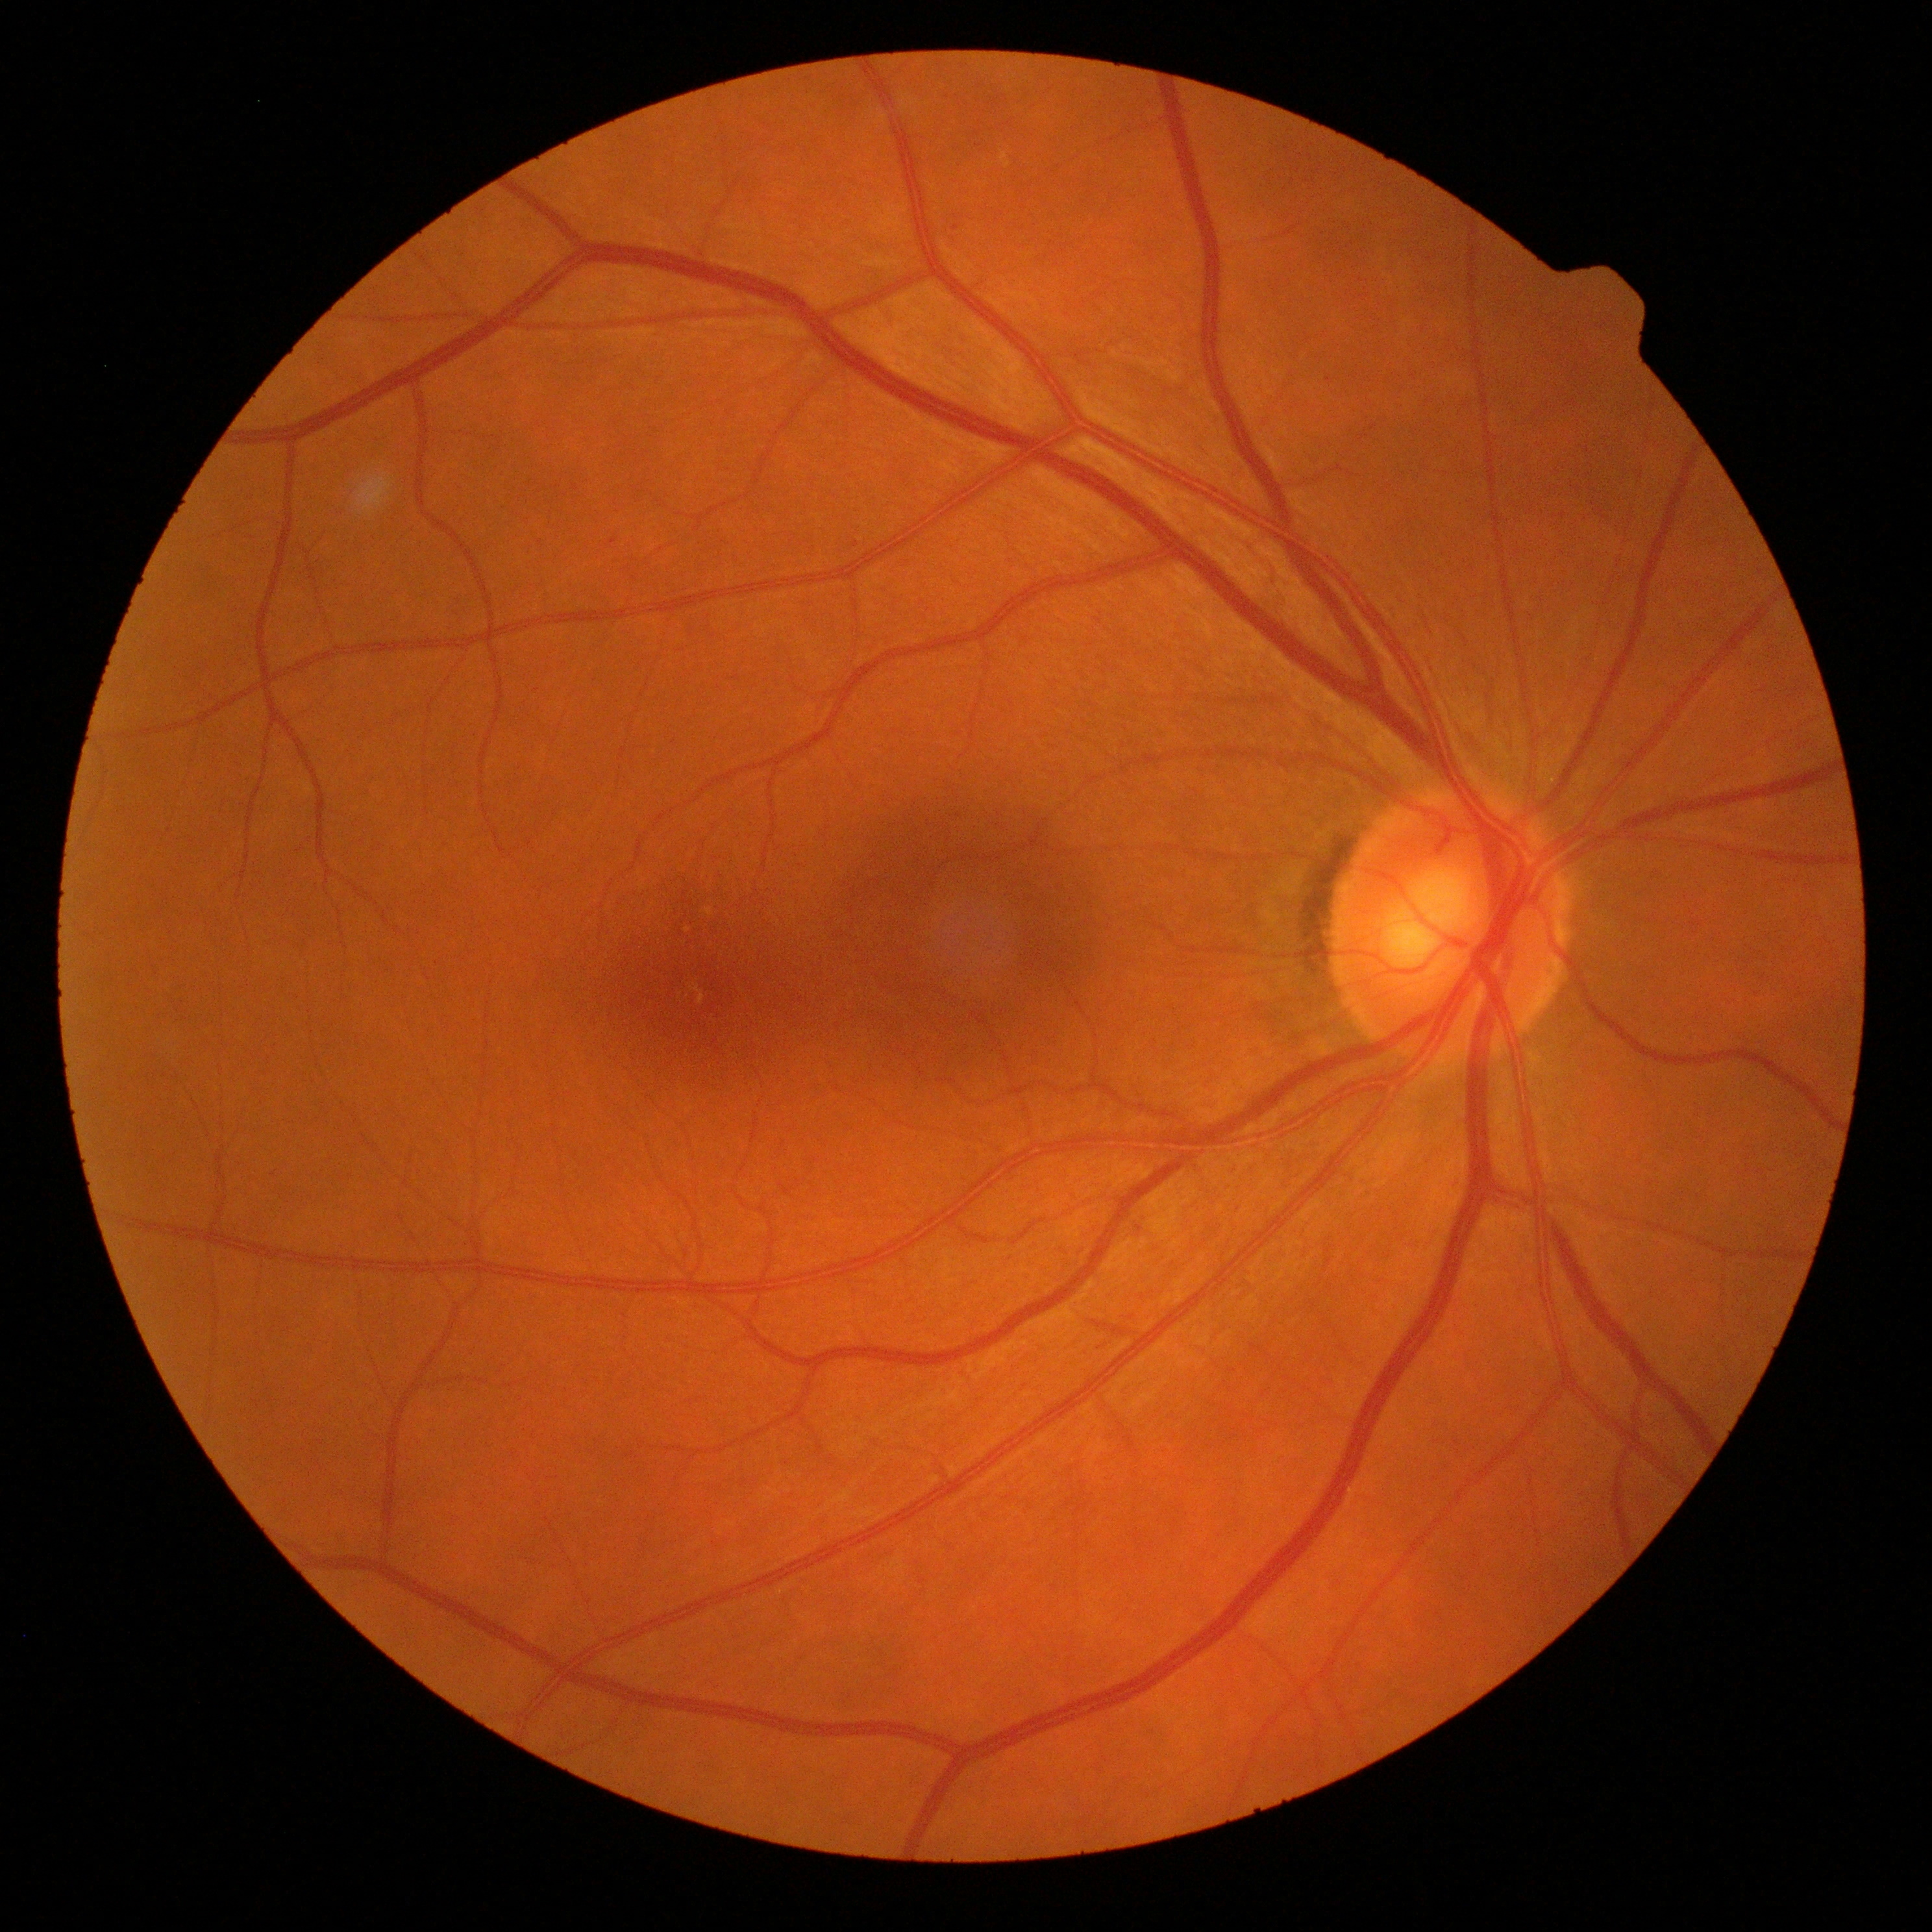
Diabetic retinopathy (DR): grade 1.